Clarity RetCam 3, 130° FOV. Pediatric retinal photograph (wide-field)
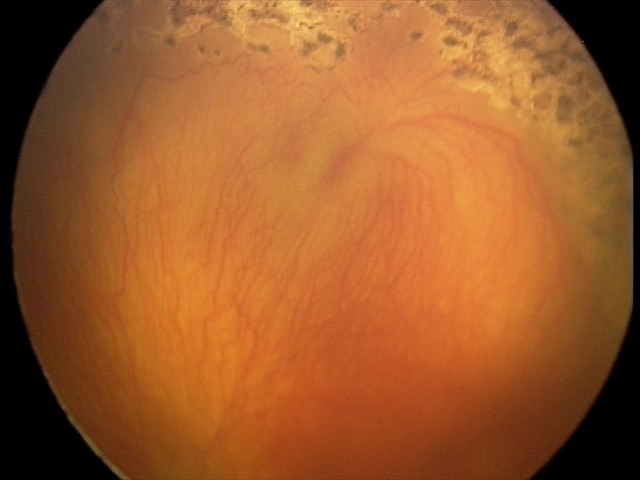 Impression: aggressive retinopathy of prematurity | plus disease.